Color fundus image — 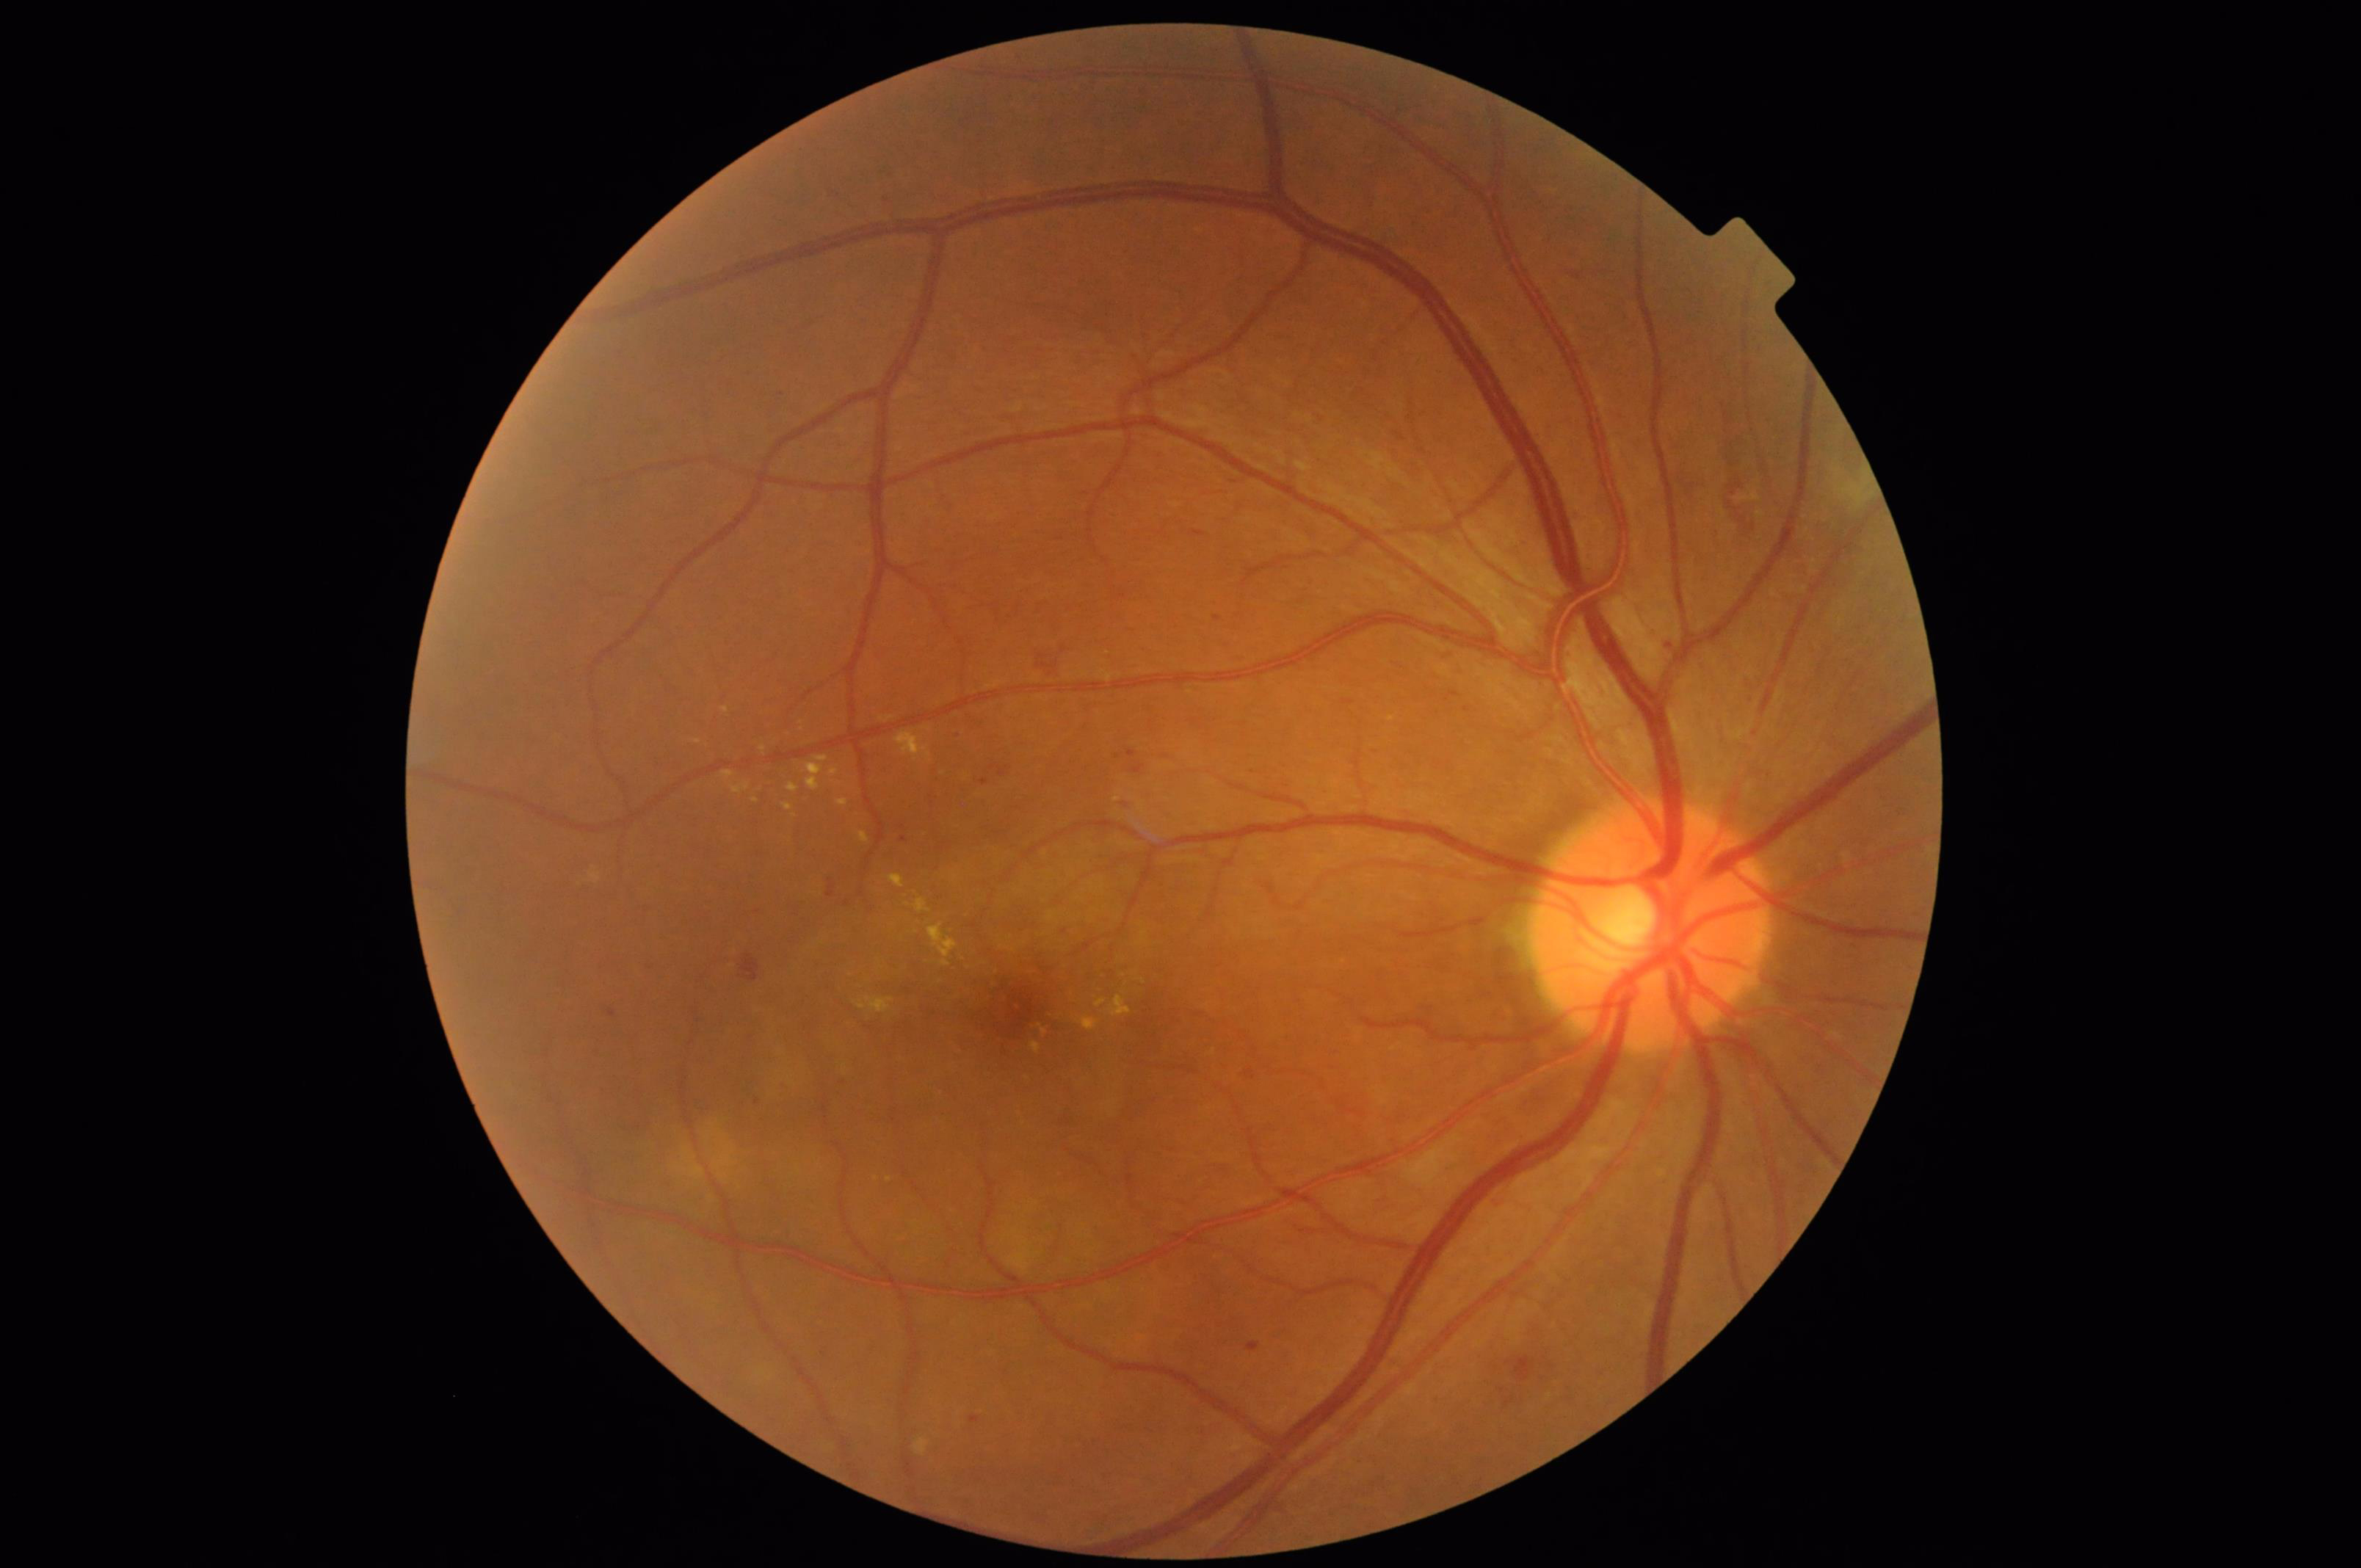 Quality grading: overall: adequate | sharpness: sharp | illumination: satisfactory.